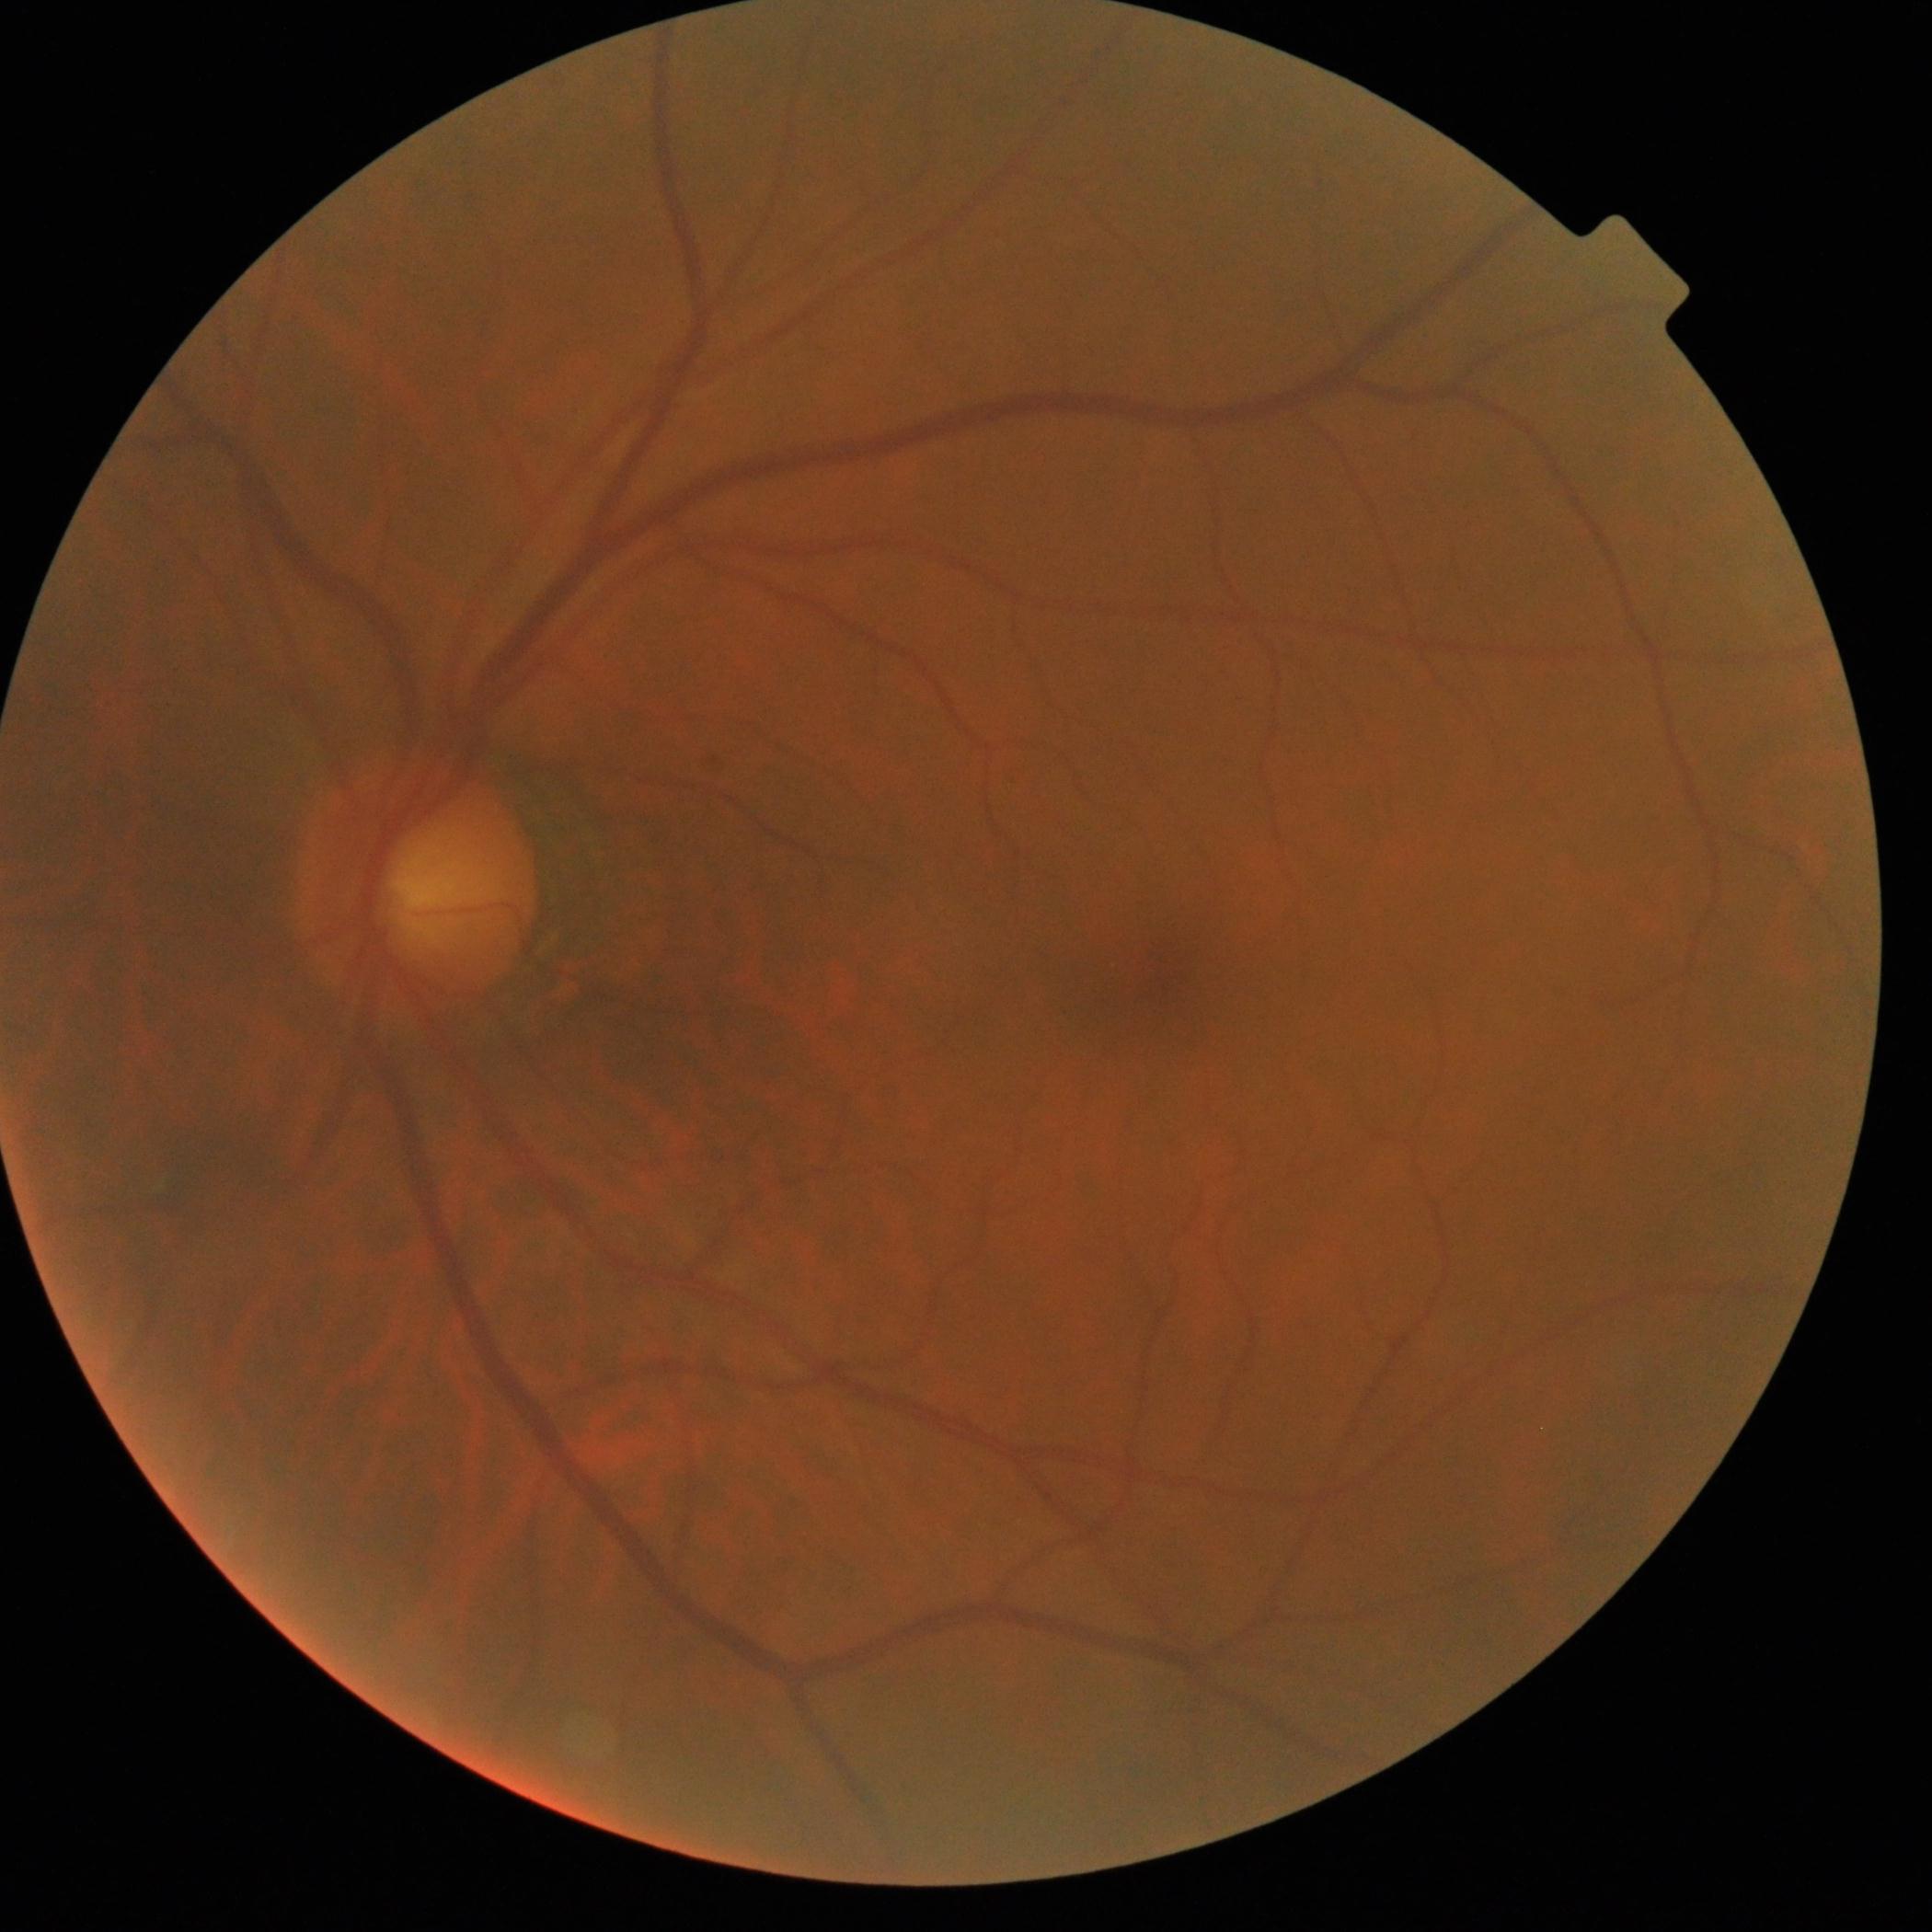
DR: 0, DR impression: no DR findings.